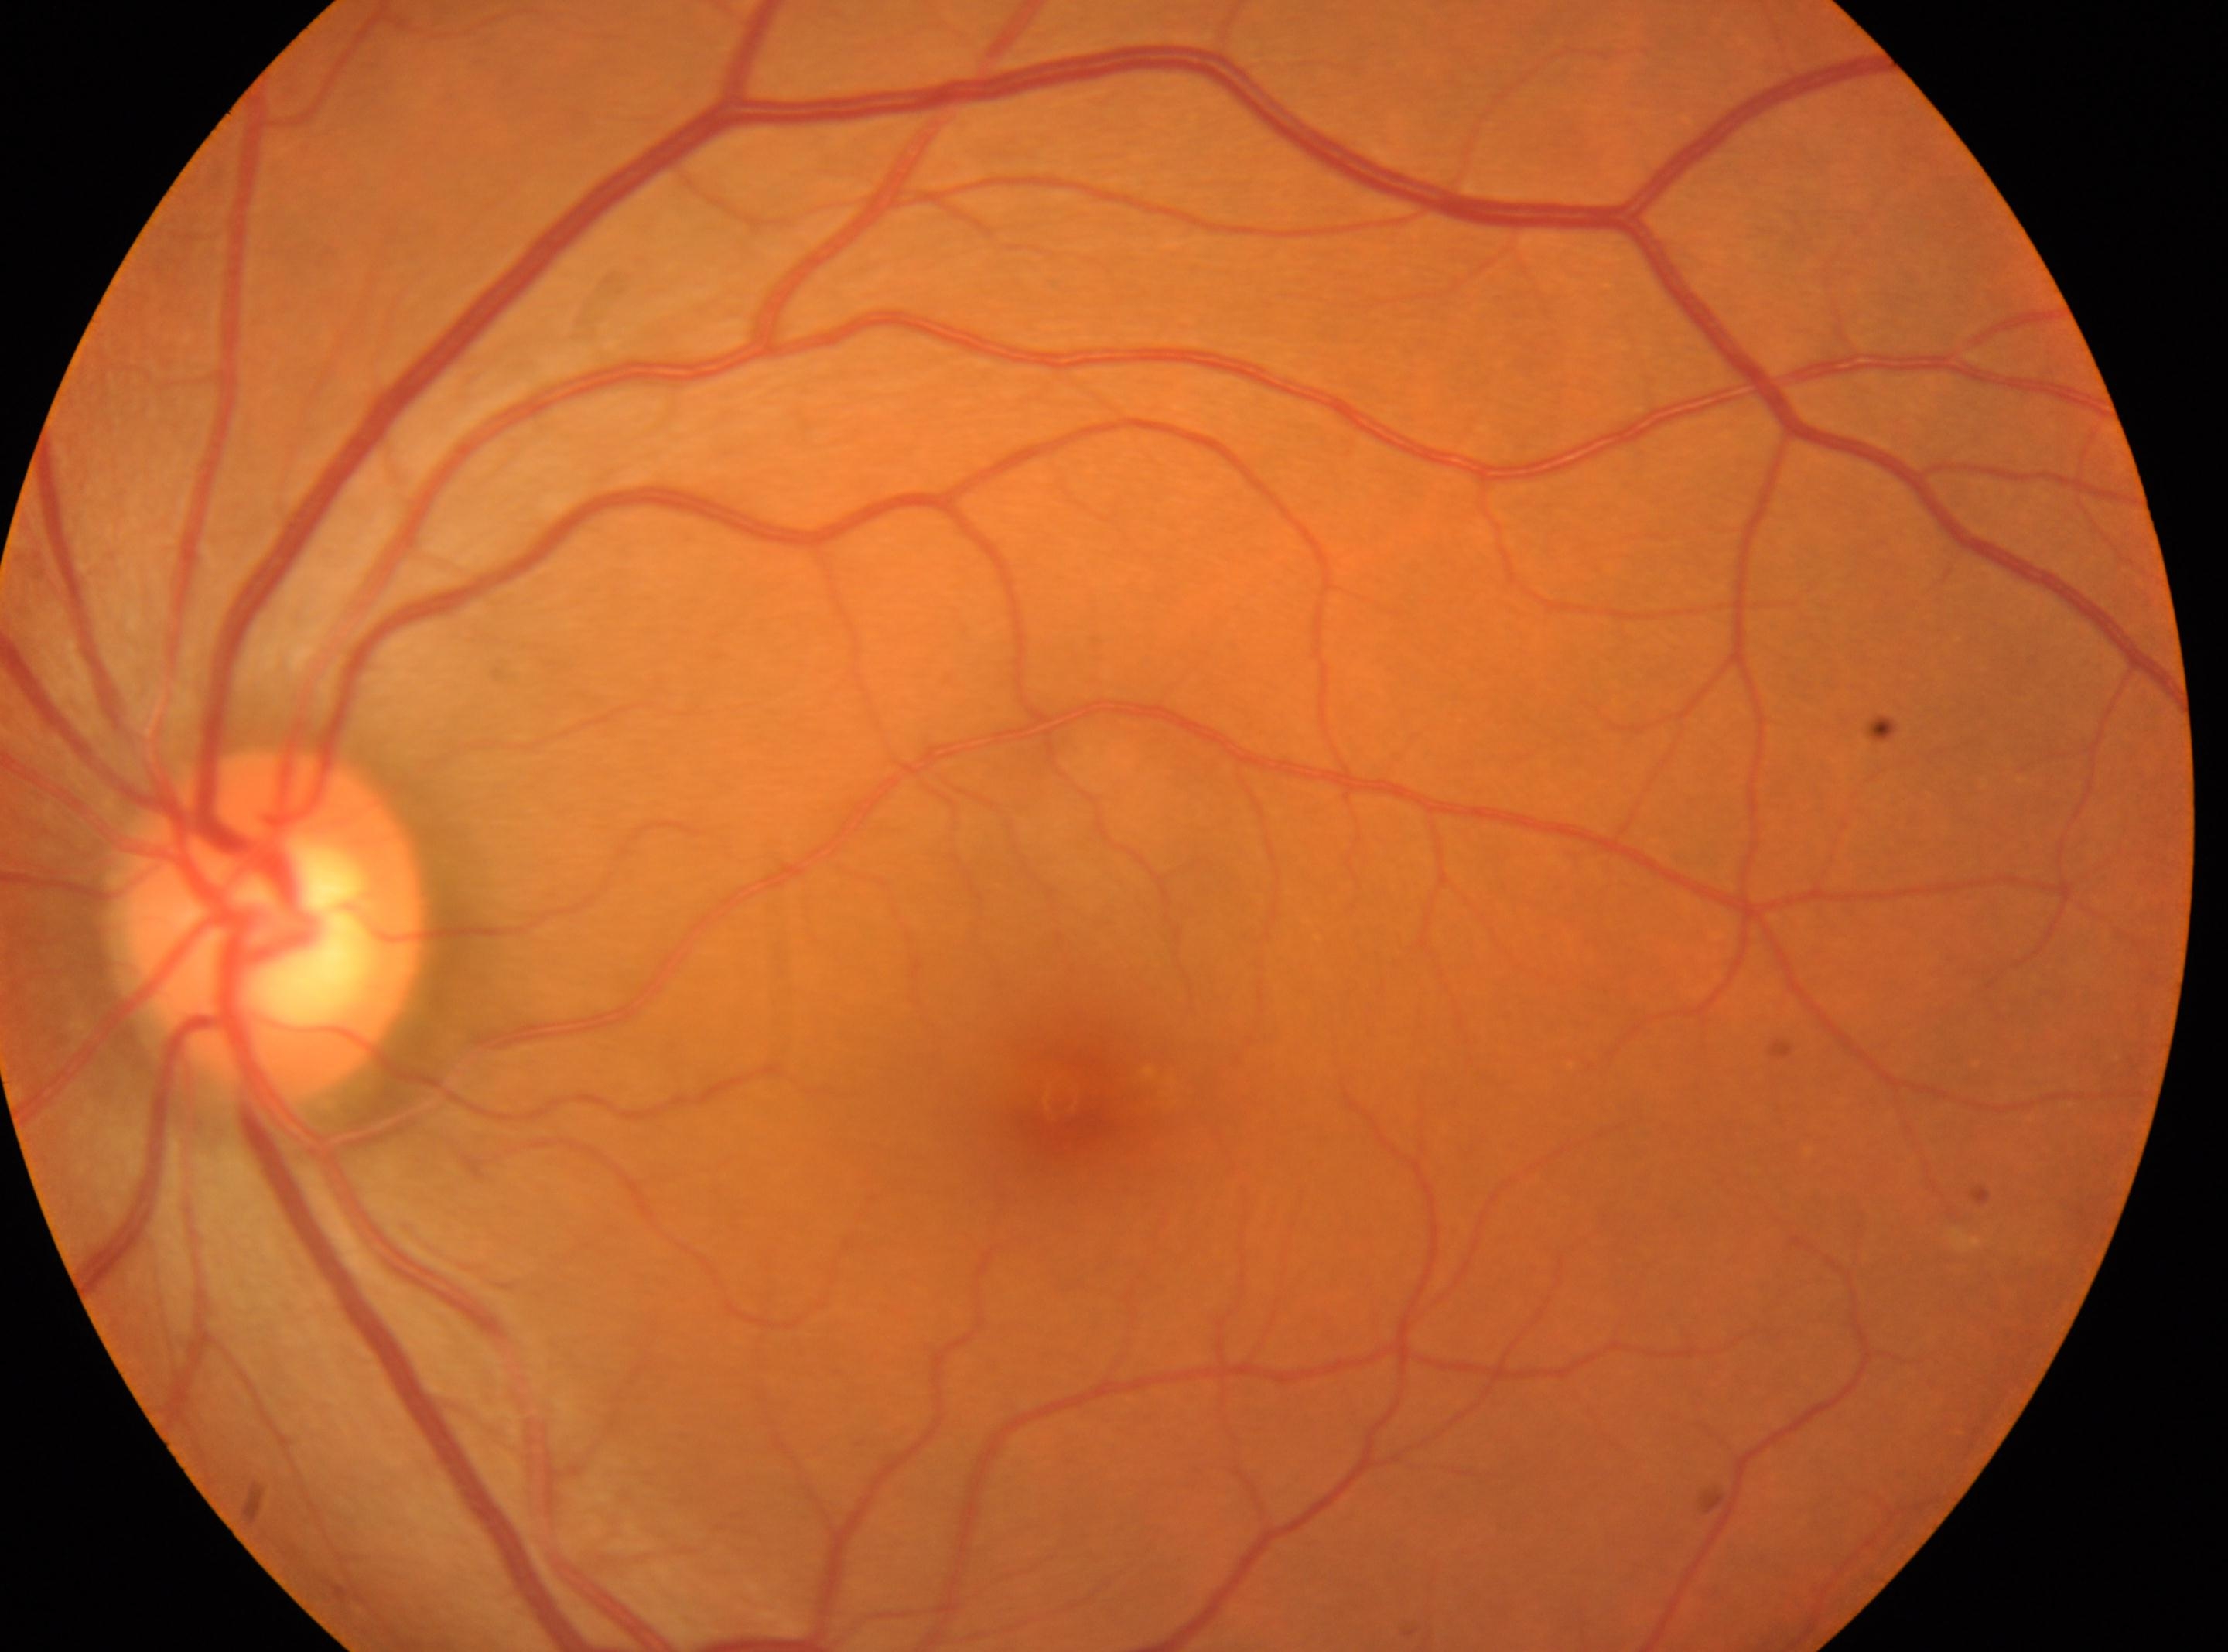
Q: Which eye is imaged?
A: left eye
Q: Locate the fovea.
A: (x=1074, y=1100)
Q: Optic disc center?
A: (x=271, y=925)
Q: DR stage?
A: 0
Q: Any diabetic retinopathy?
A: No apparent diabetic retinopathy